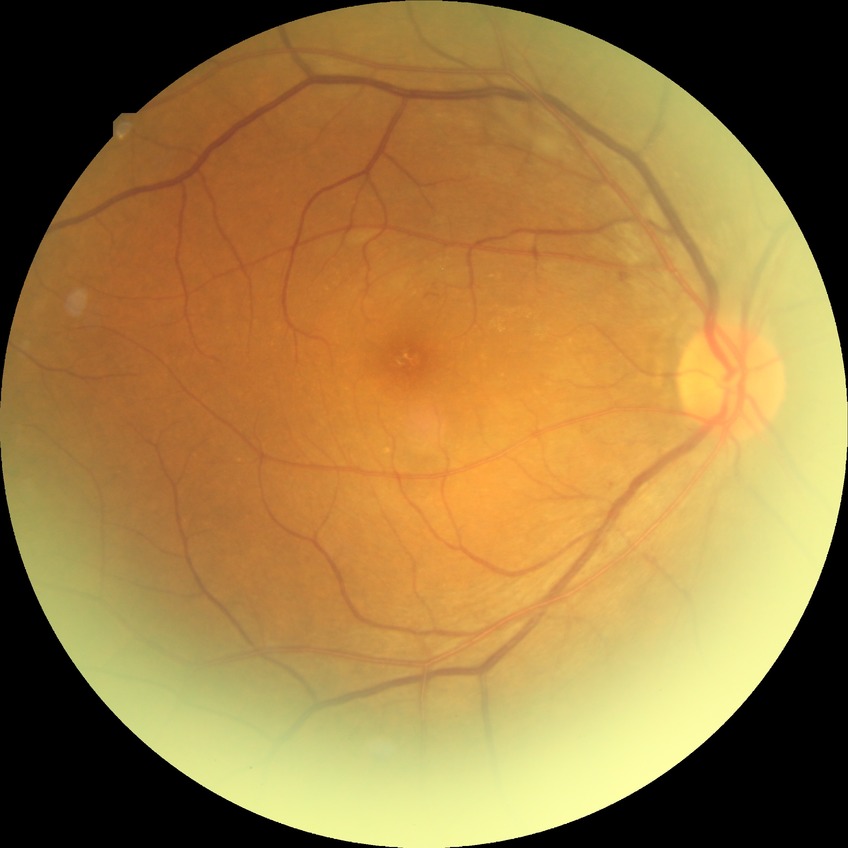
Annotations:
* DR class — non-proliferative diabetic retinopathy
* Davis grade — SDR